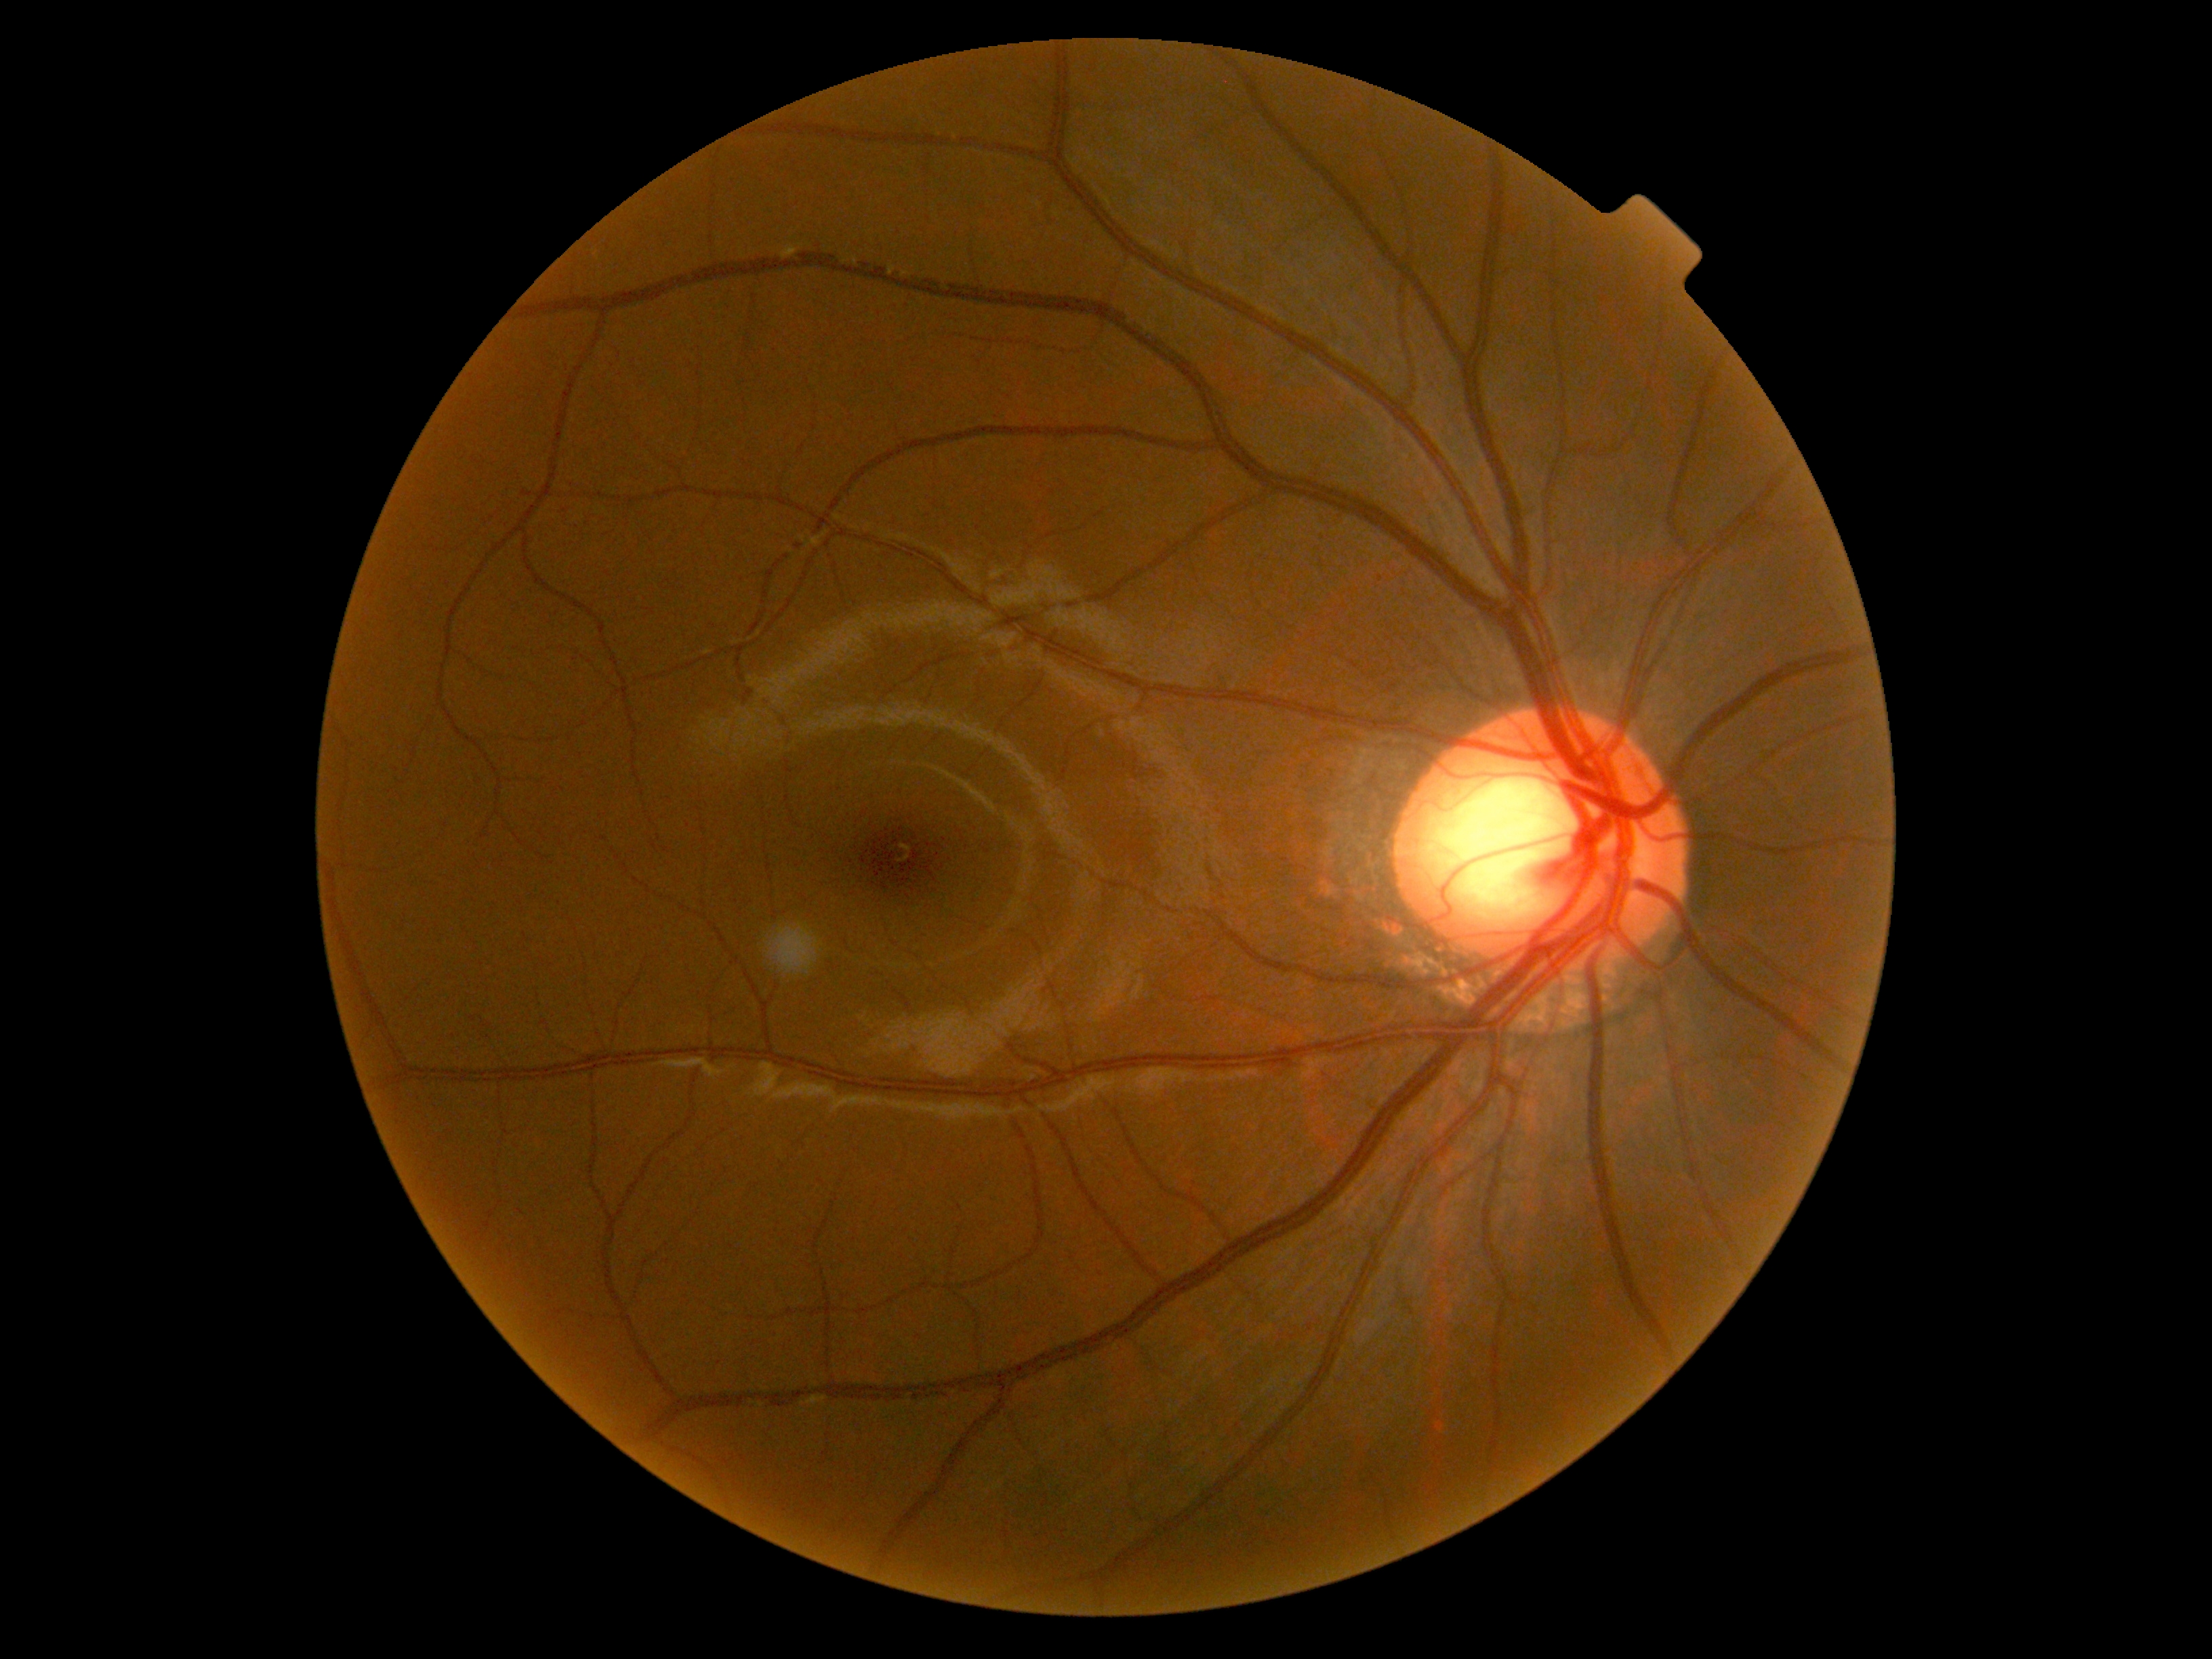
No signs of diabetic retinopathy. DR grade is no apparent retinopathy (0) — no visible signs of diabetic retinopathy.